Tabletop color fundus camera image · 50-degree field of view · 1924 x 1556 pixels:
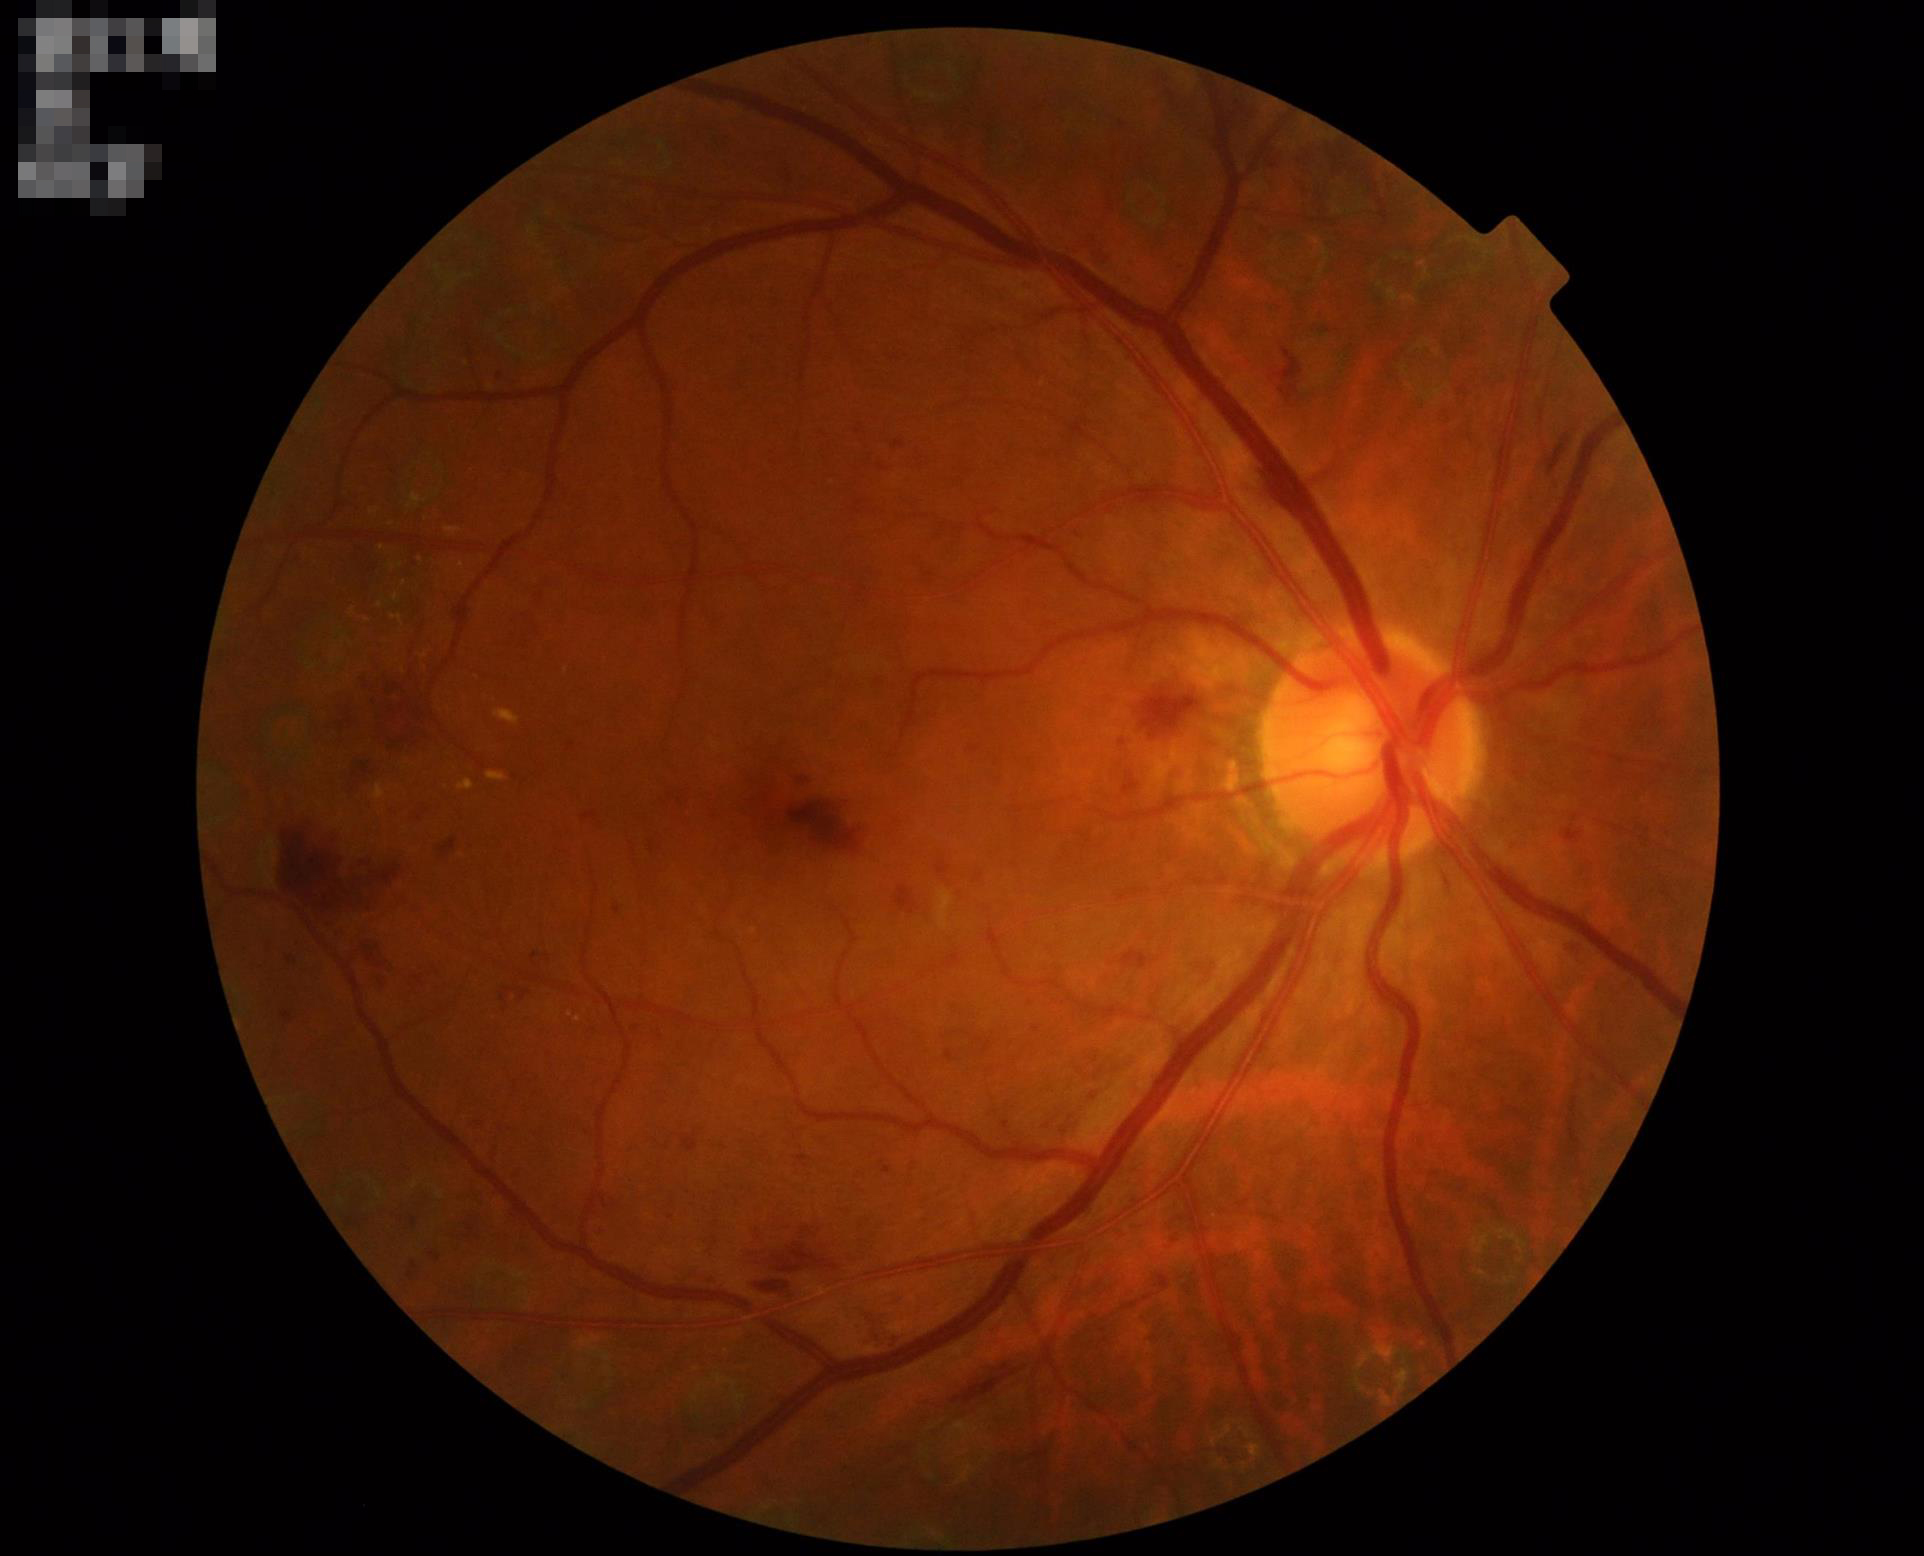
The image is clear. Overall image quality is good. No over- or under-exposure.